FOV: 45 degrees:
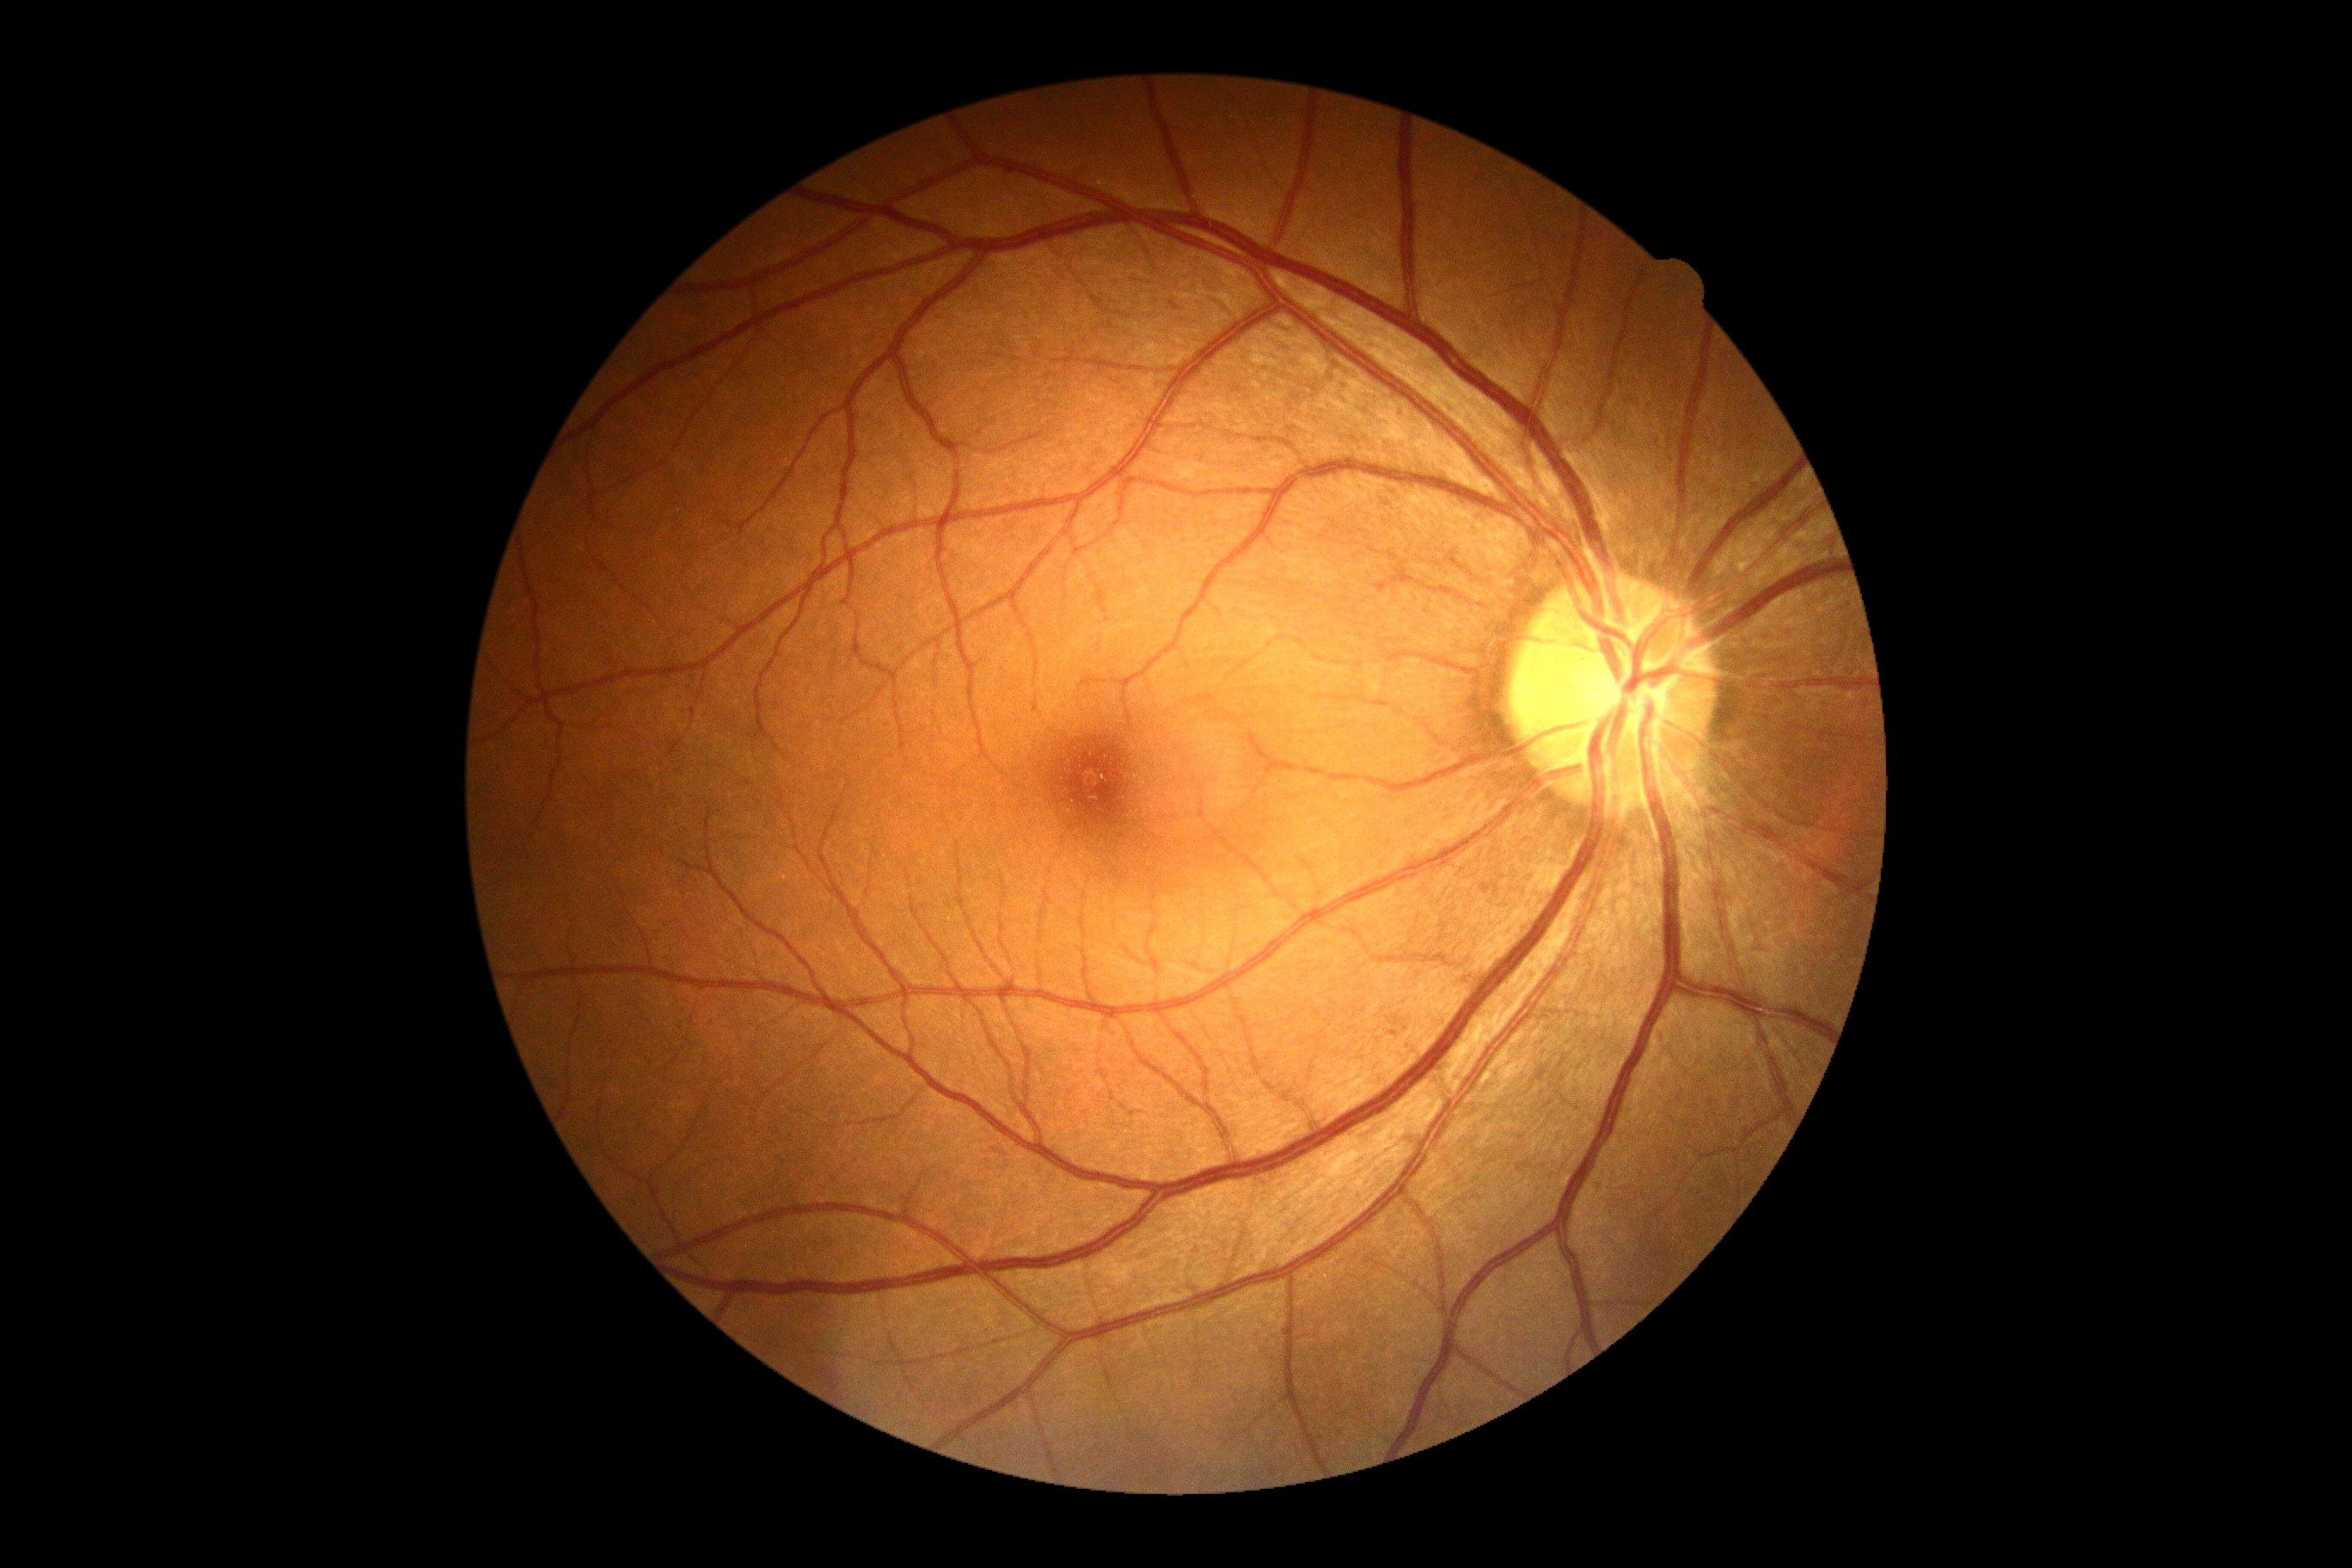
No DR findings. Diabetic retinopathy grade is no apparent diabetic retinopathy (0).